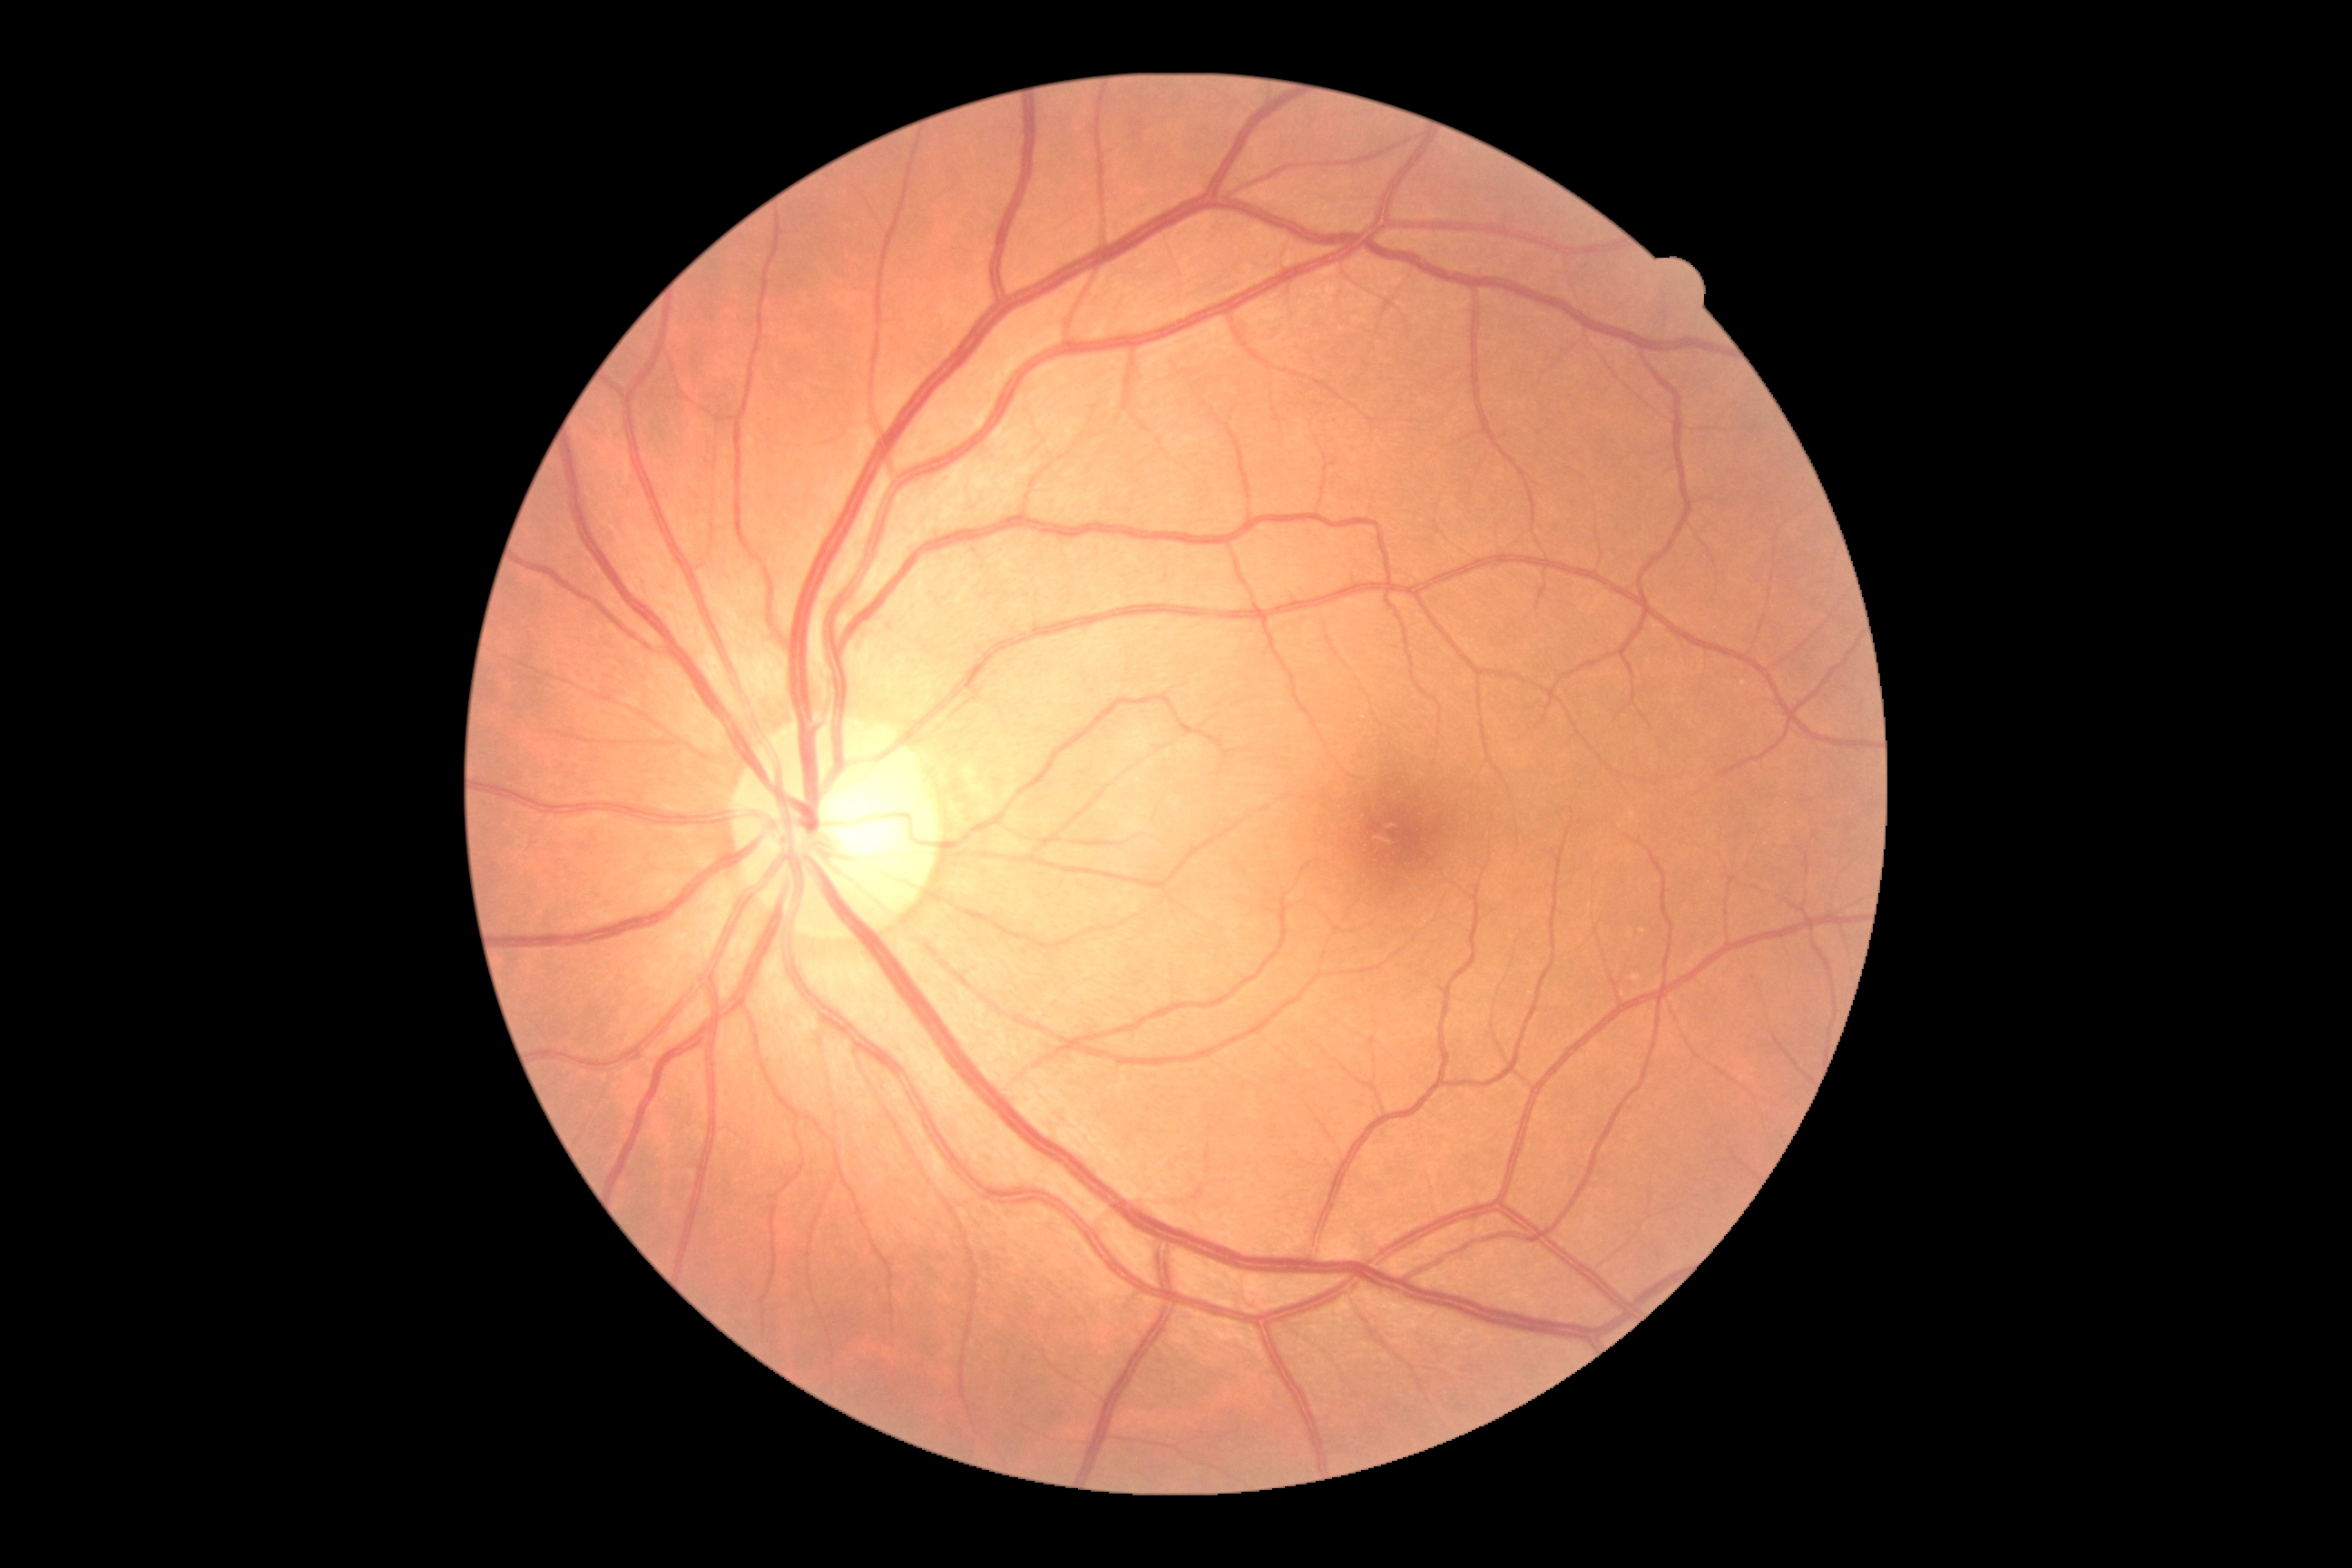

Annotations:
* diabetic retinopathy (DR) — grade 0
* DR impression — no signs of DR